Image size 1380x1382
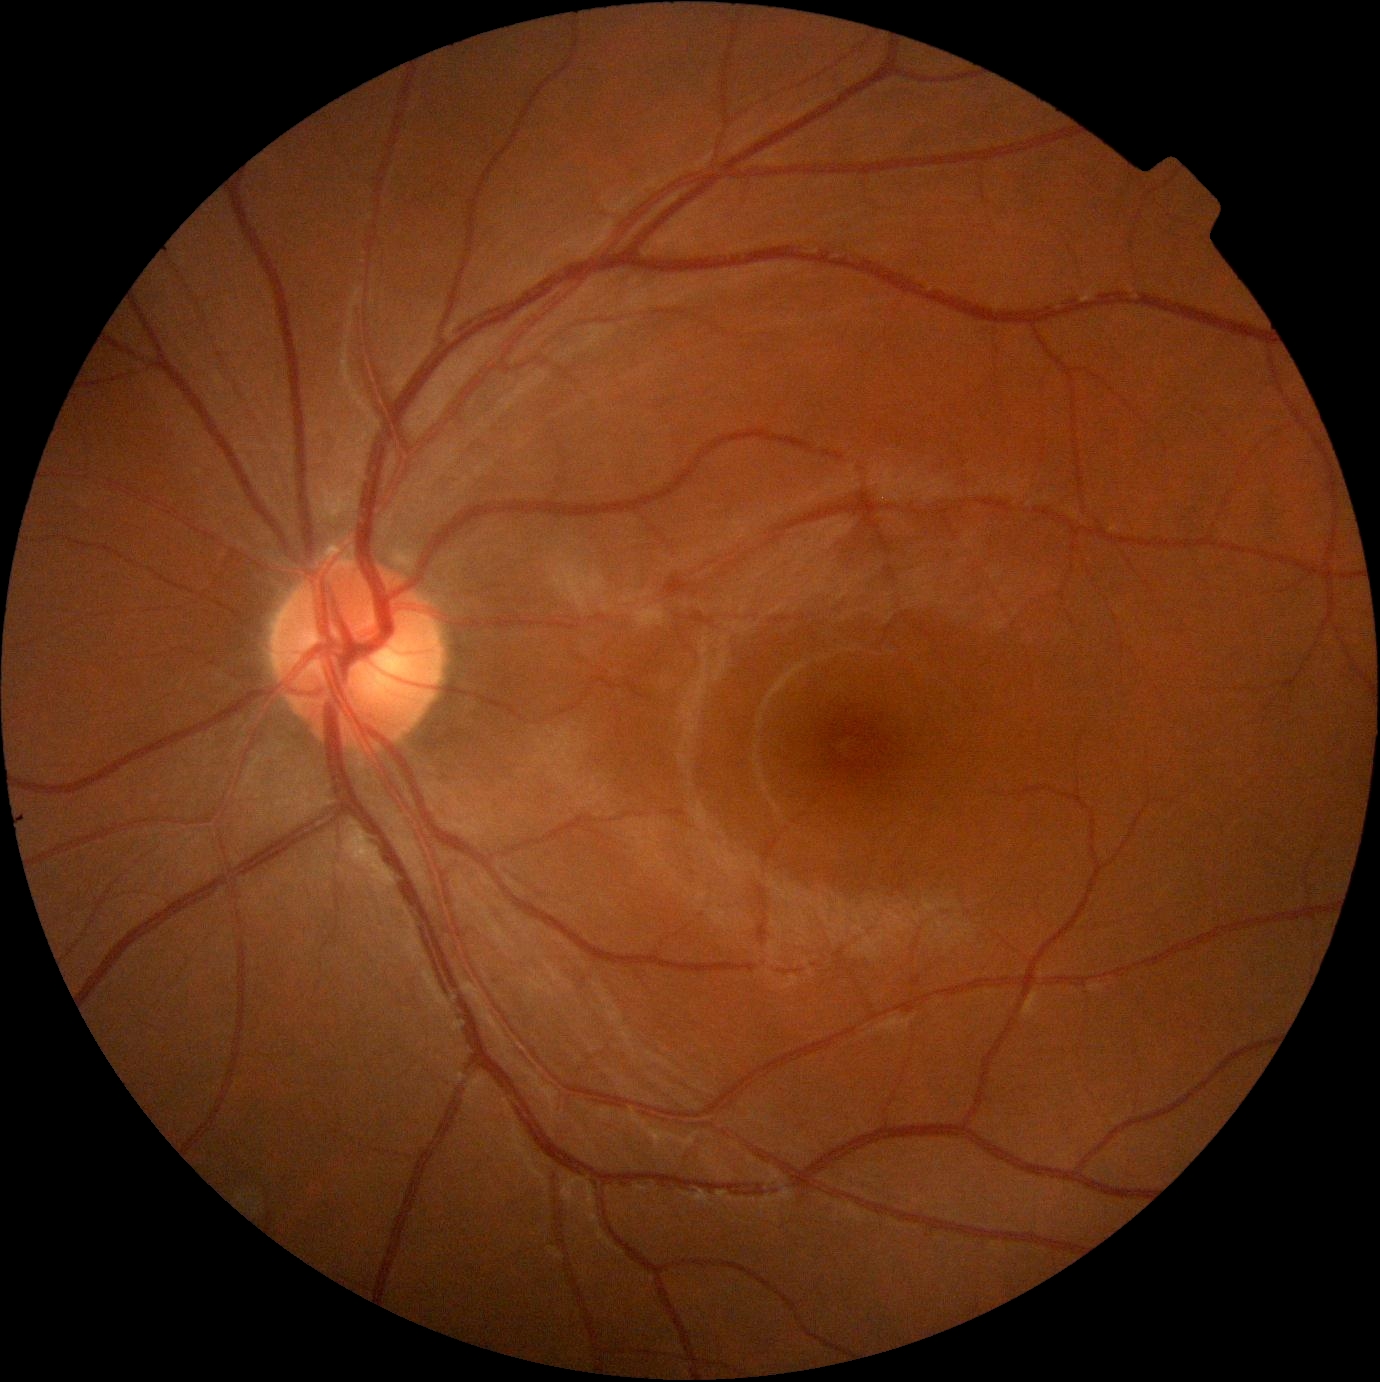
DR@grade 0 (no apparent retinopathy).